45 degree fundus photograph. 848x848px
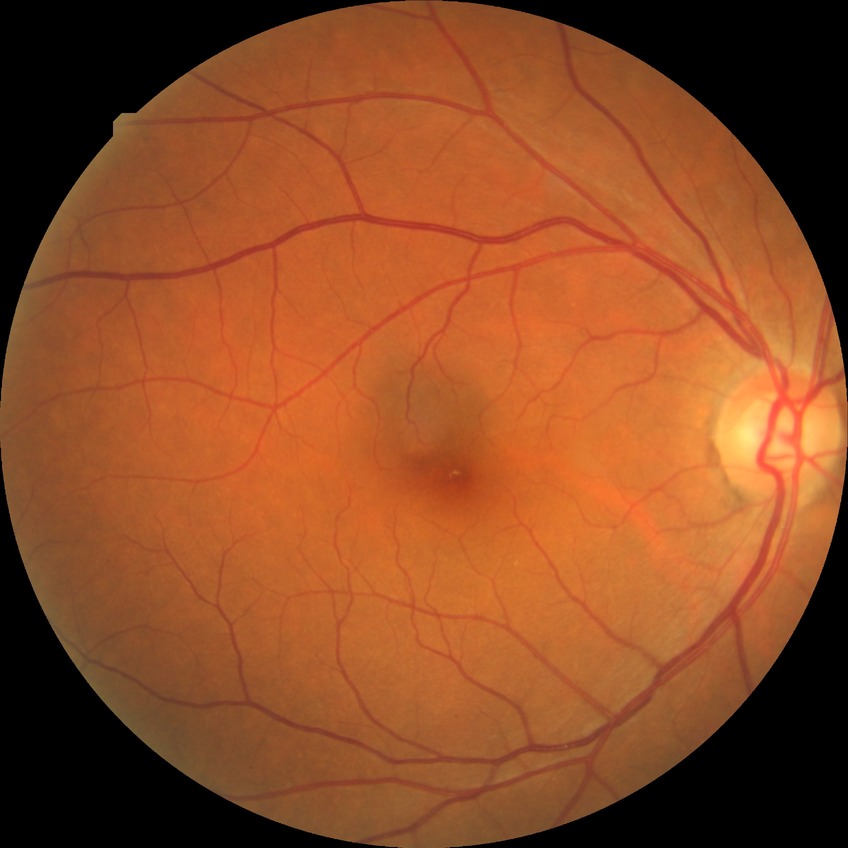

Findings:
• diabetic retinopathy (DR): NDR (no diabetic retinopathy)